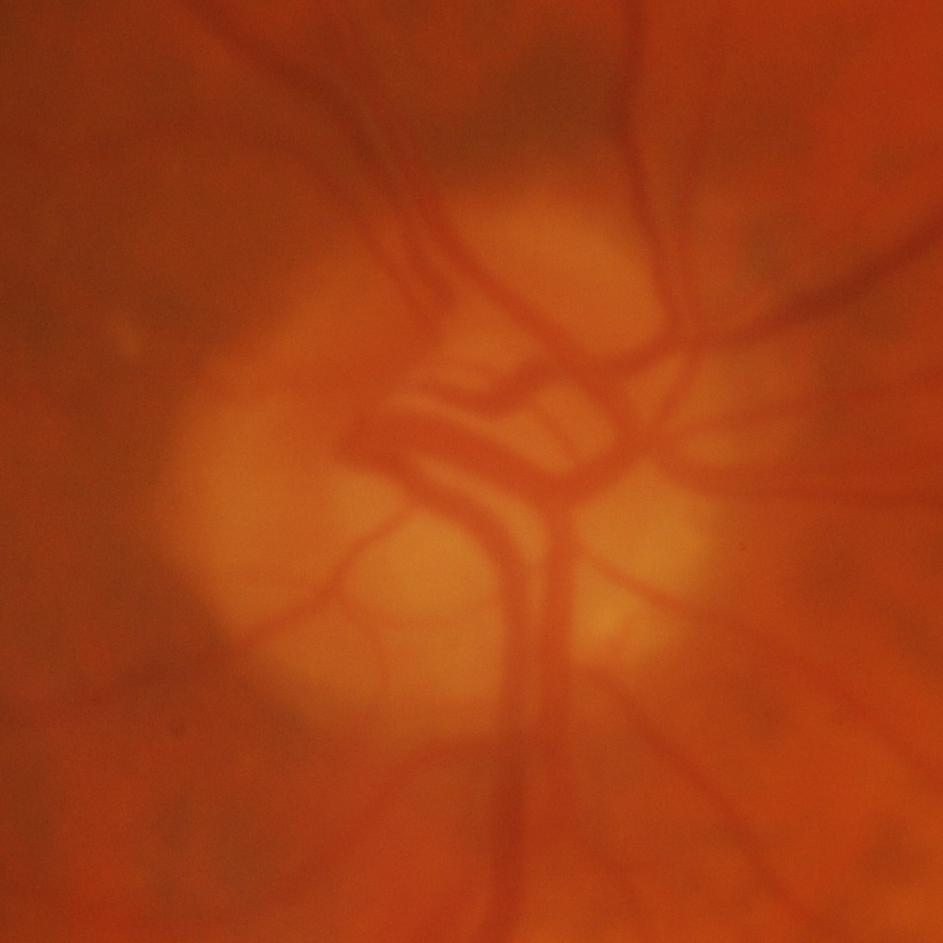
Glaucomatous optic neuropathy is present. Impression: evidence of glaucoma.